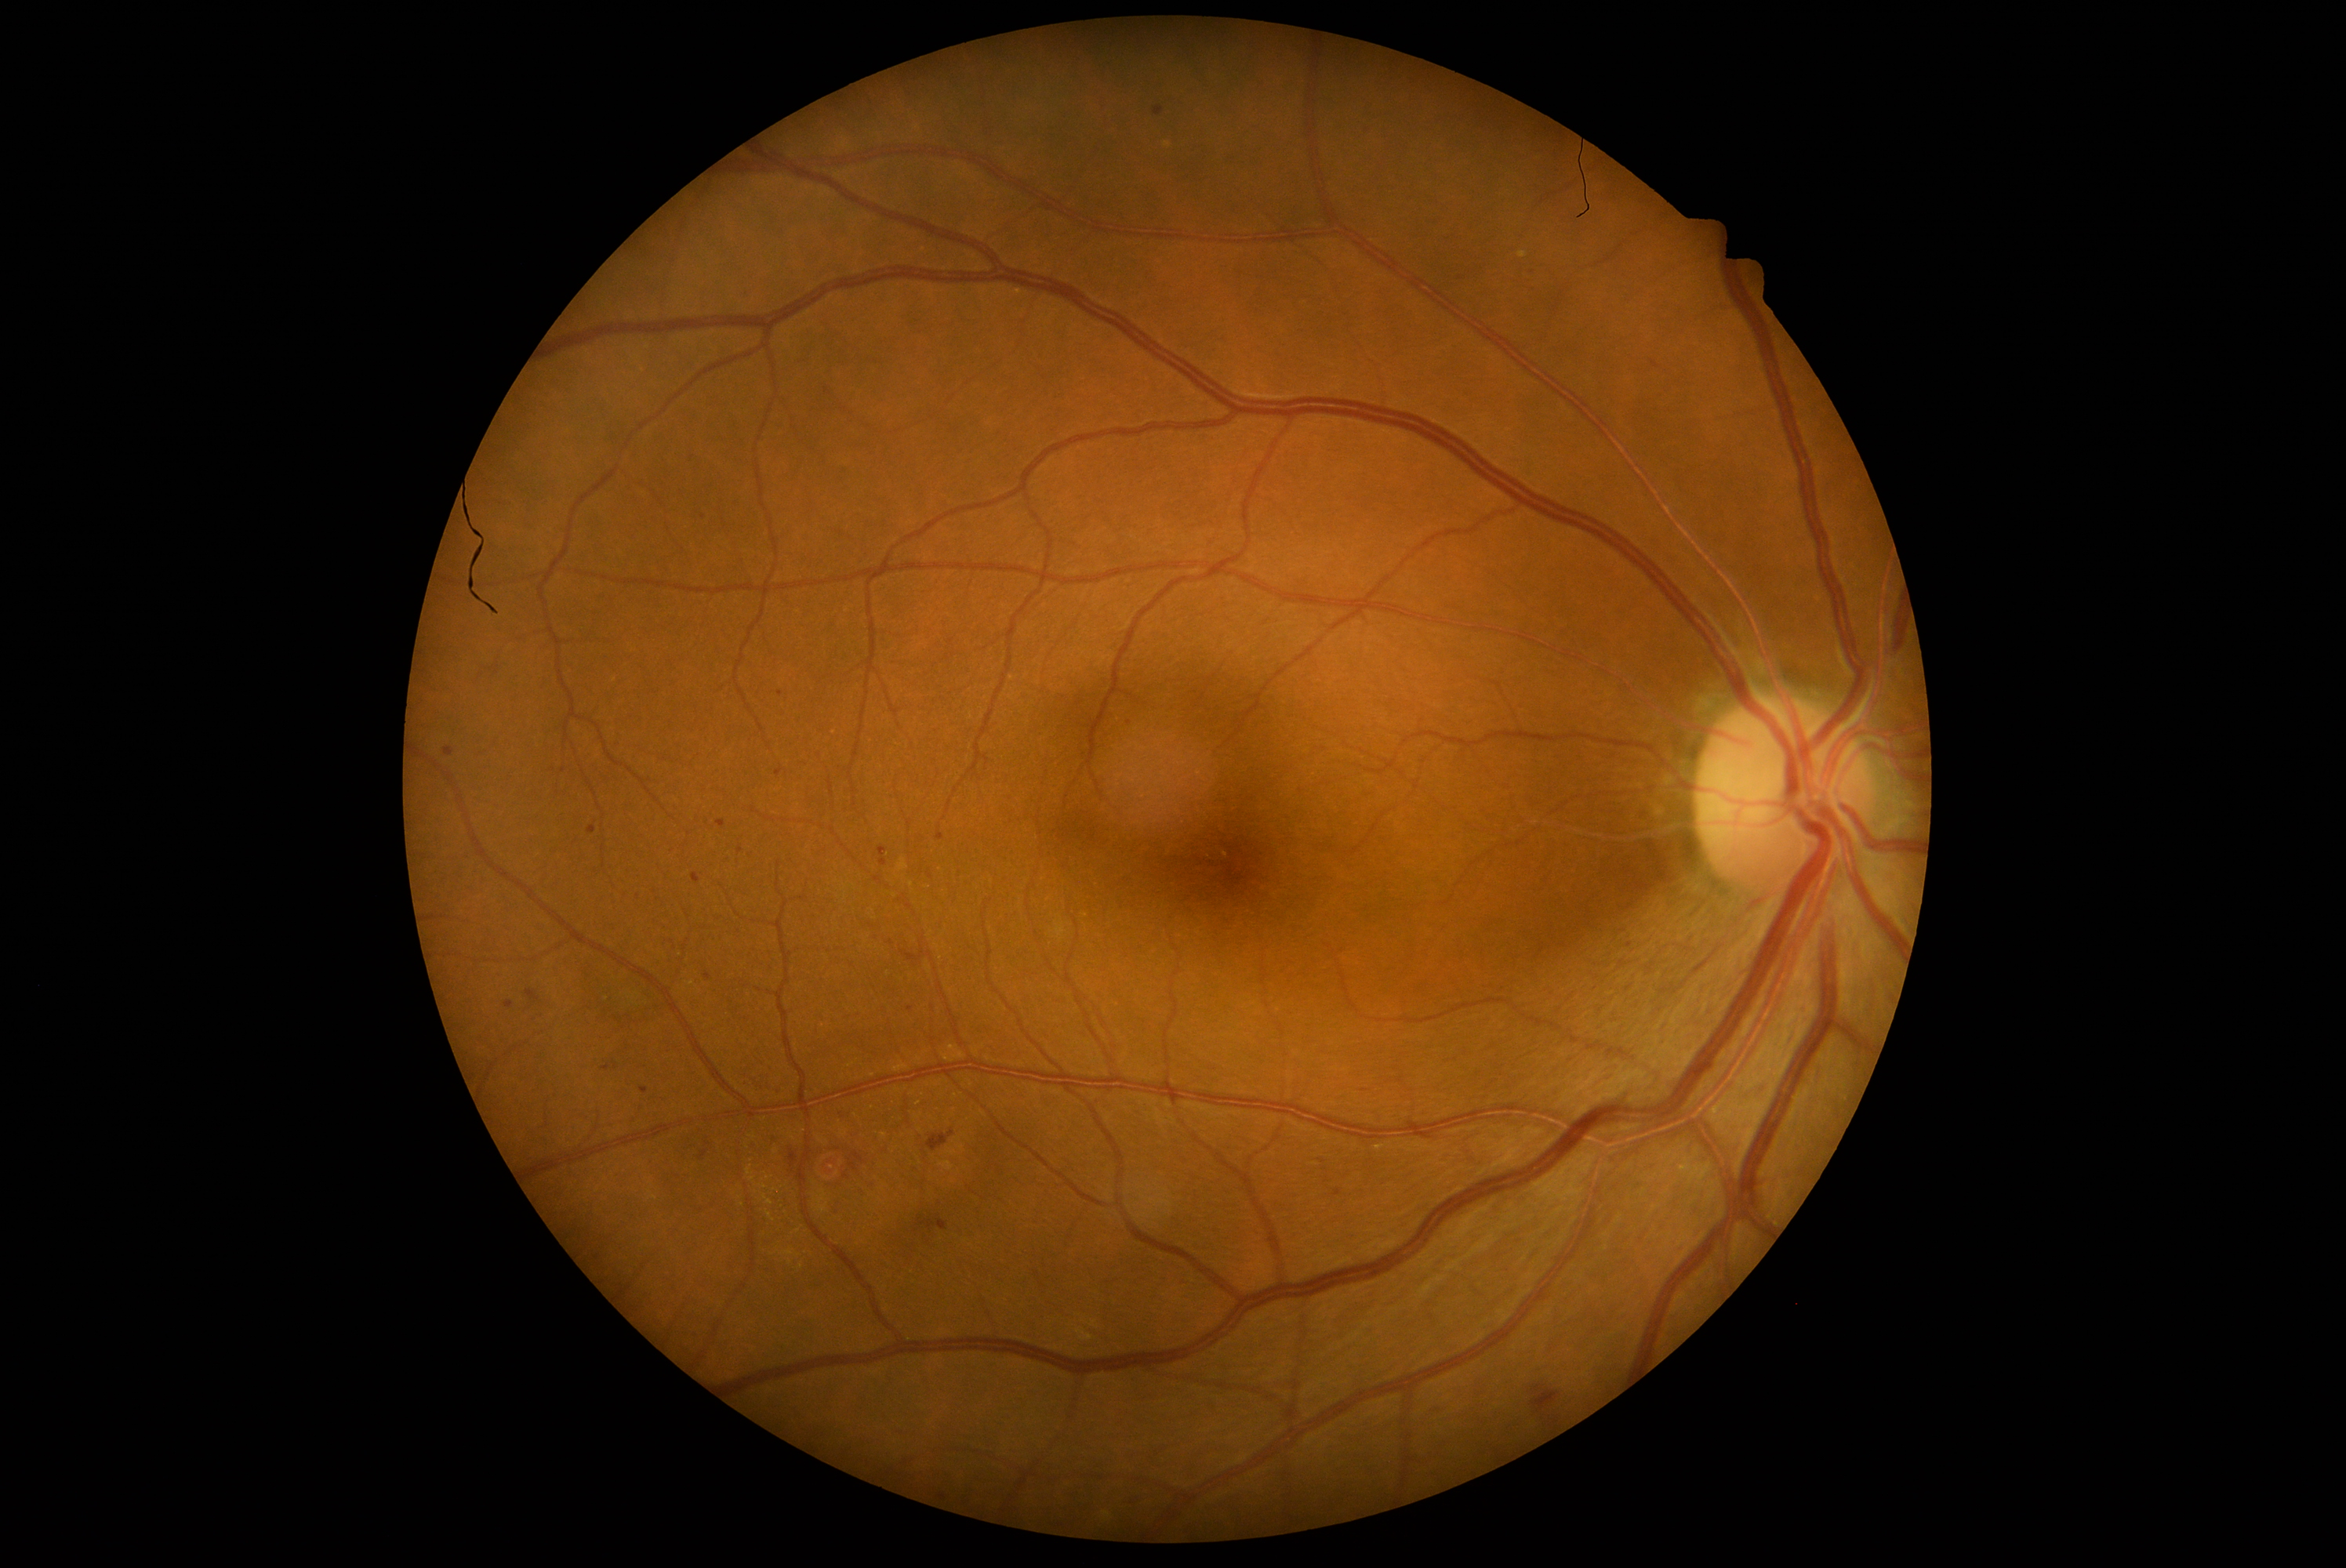
Diabetic retinopathy is moderate non-proliferative diabetic retinopathy (grade 2).